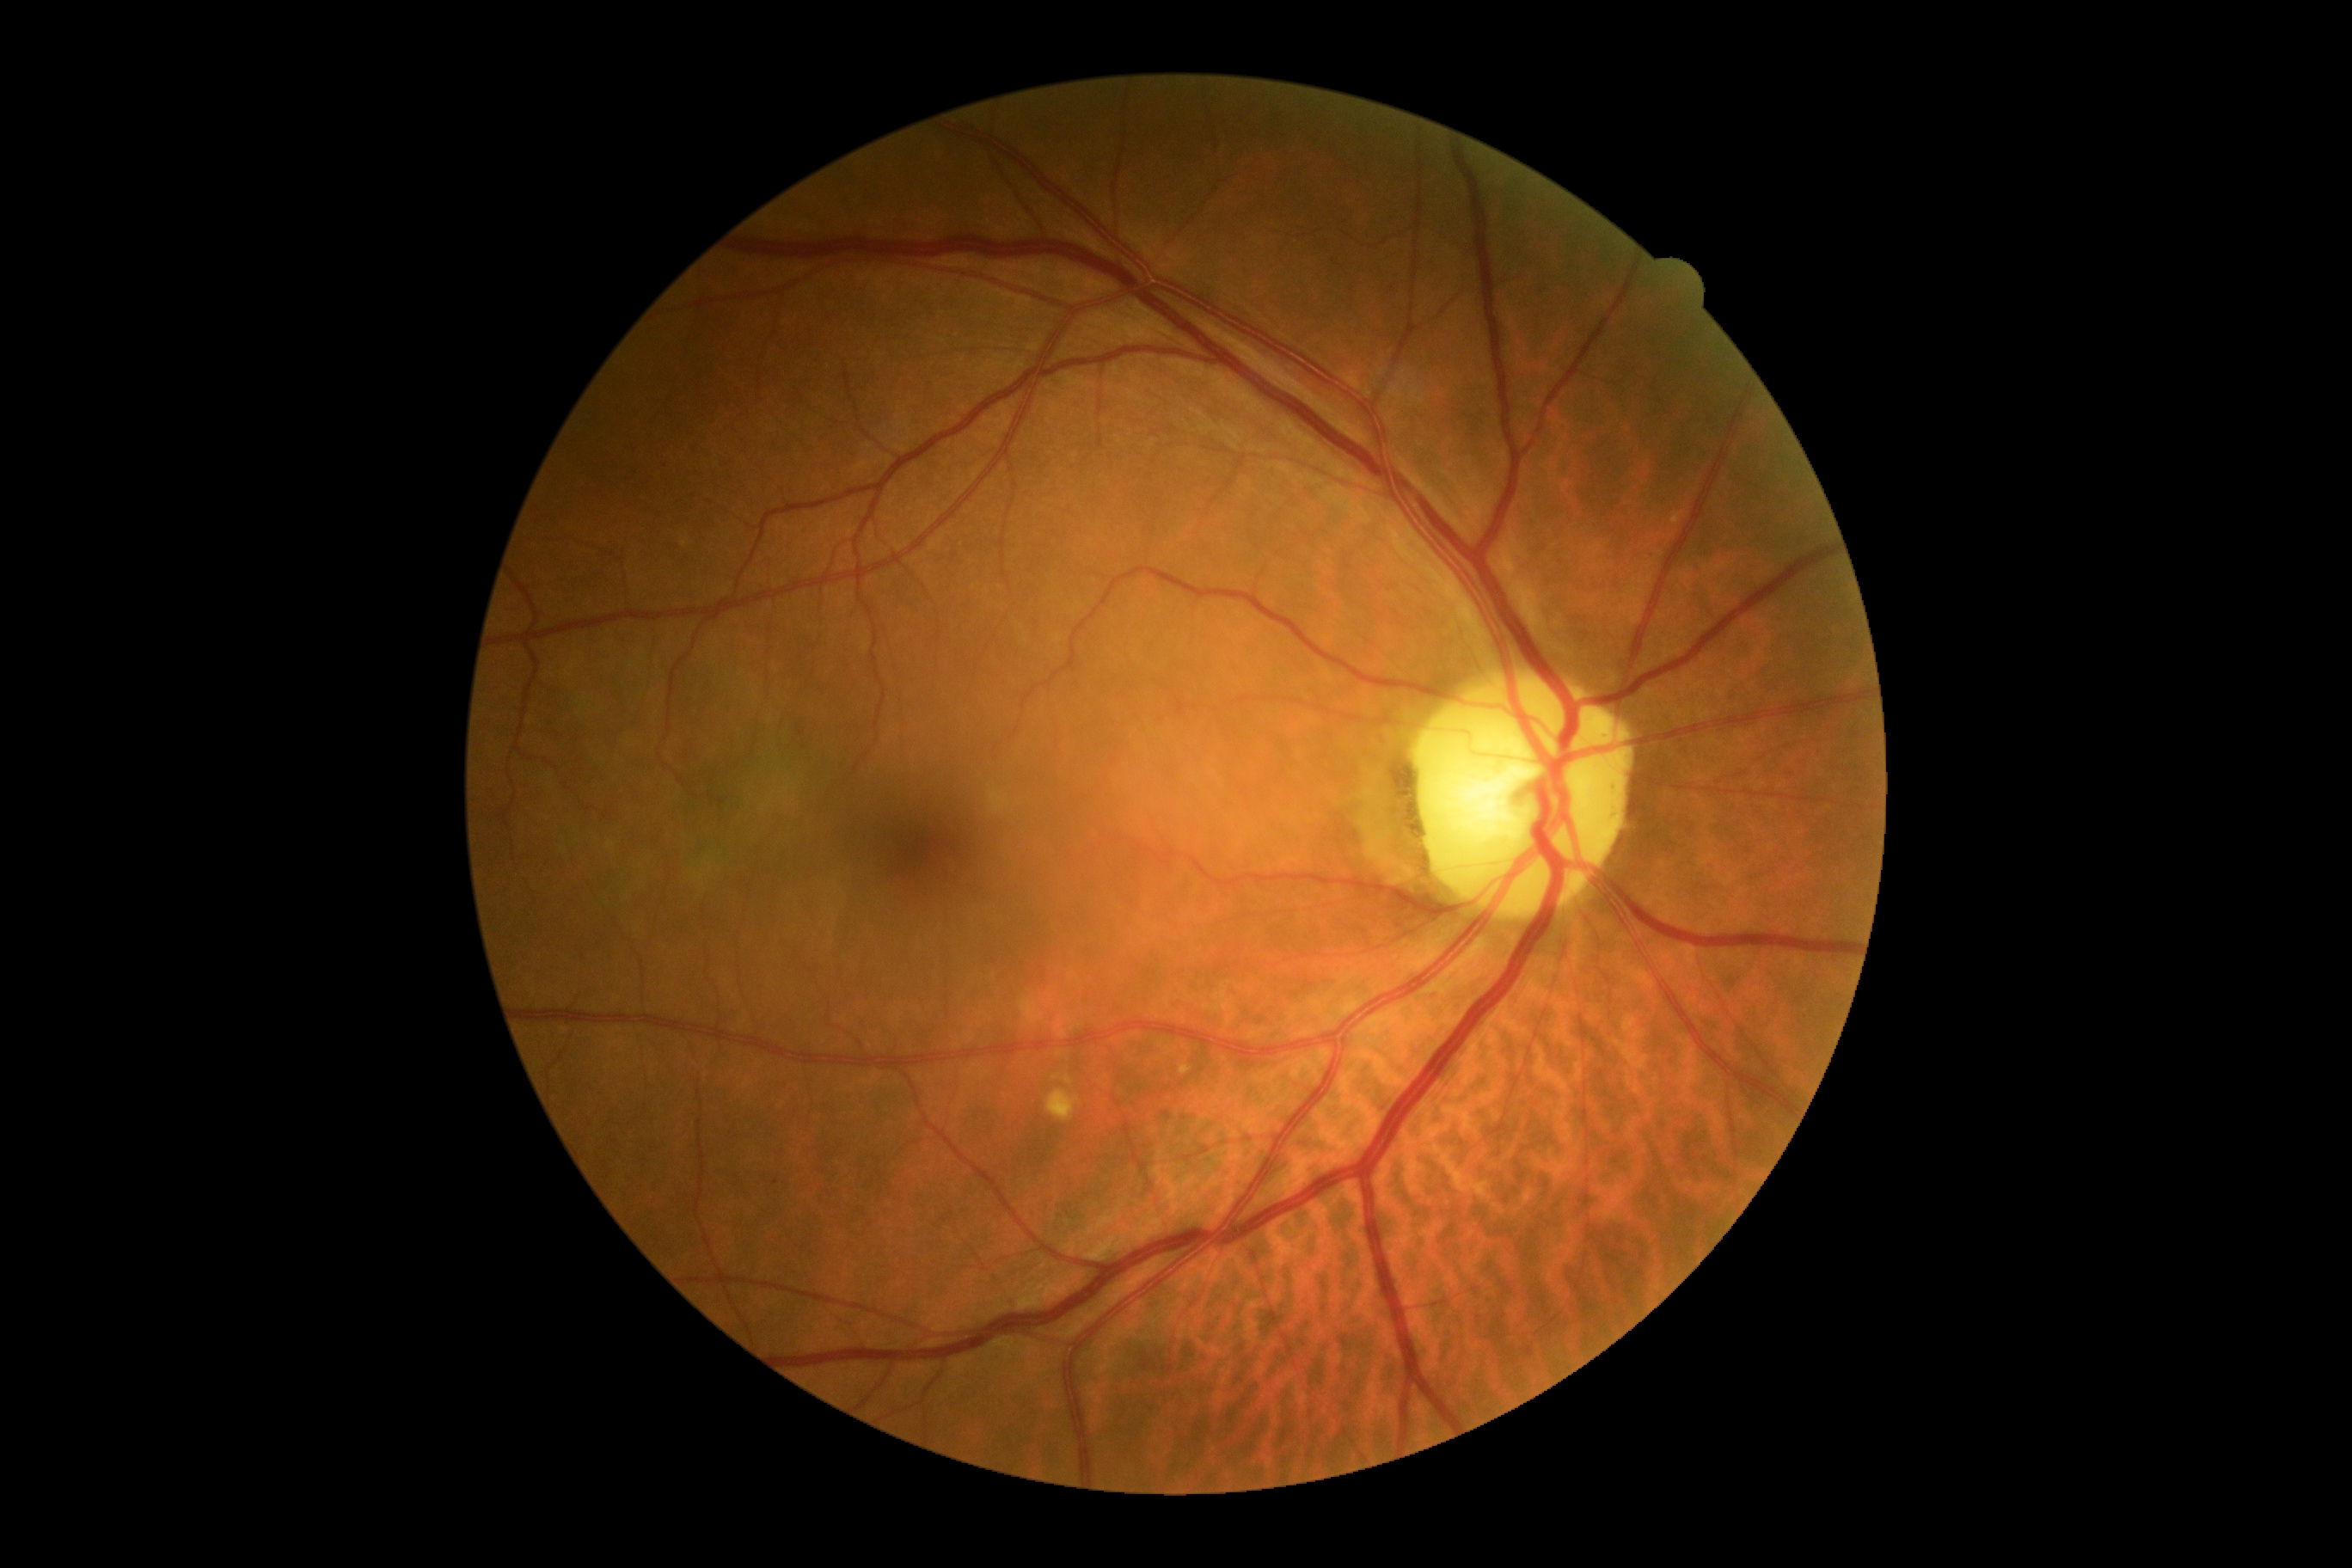
Diabetic retinopathy (DR): grade 0 (no apparent retinopathy).
No signs of diabetic retinopathy.